Captured with the Clarity RetCam 3 (130° field of view); infant wide-field fundus photograph: 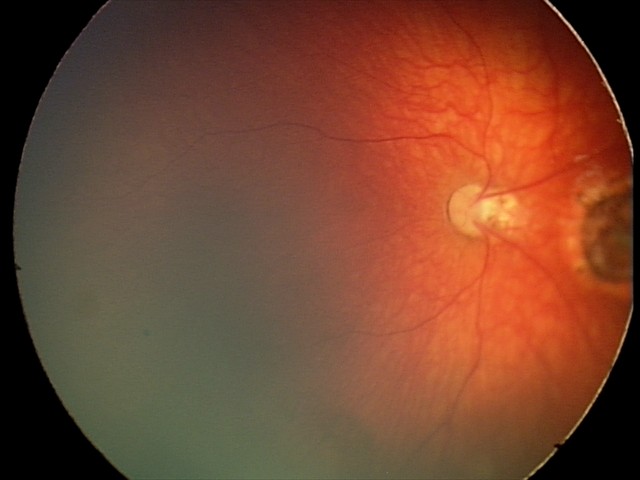

Assessment: toxoplasmosis chorioretinitis.